1659x2212. CFP — 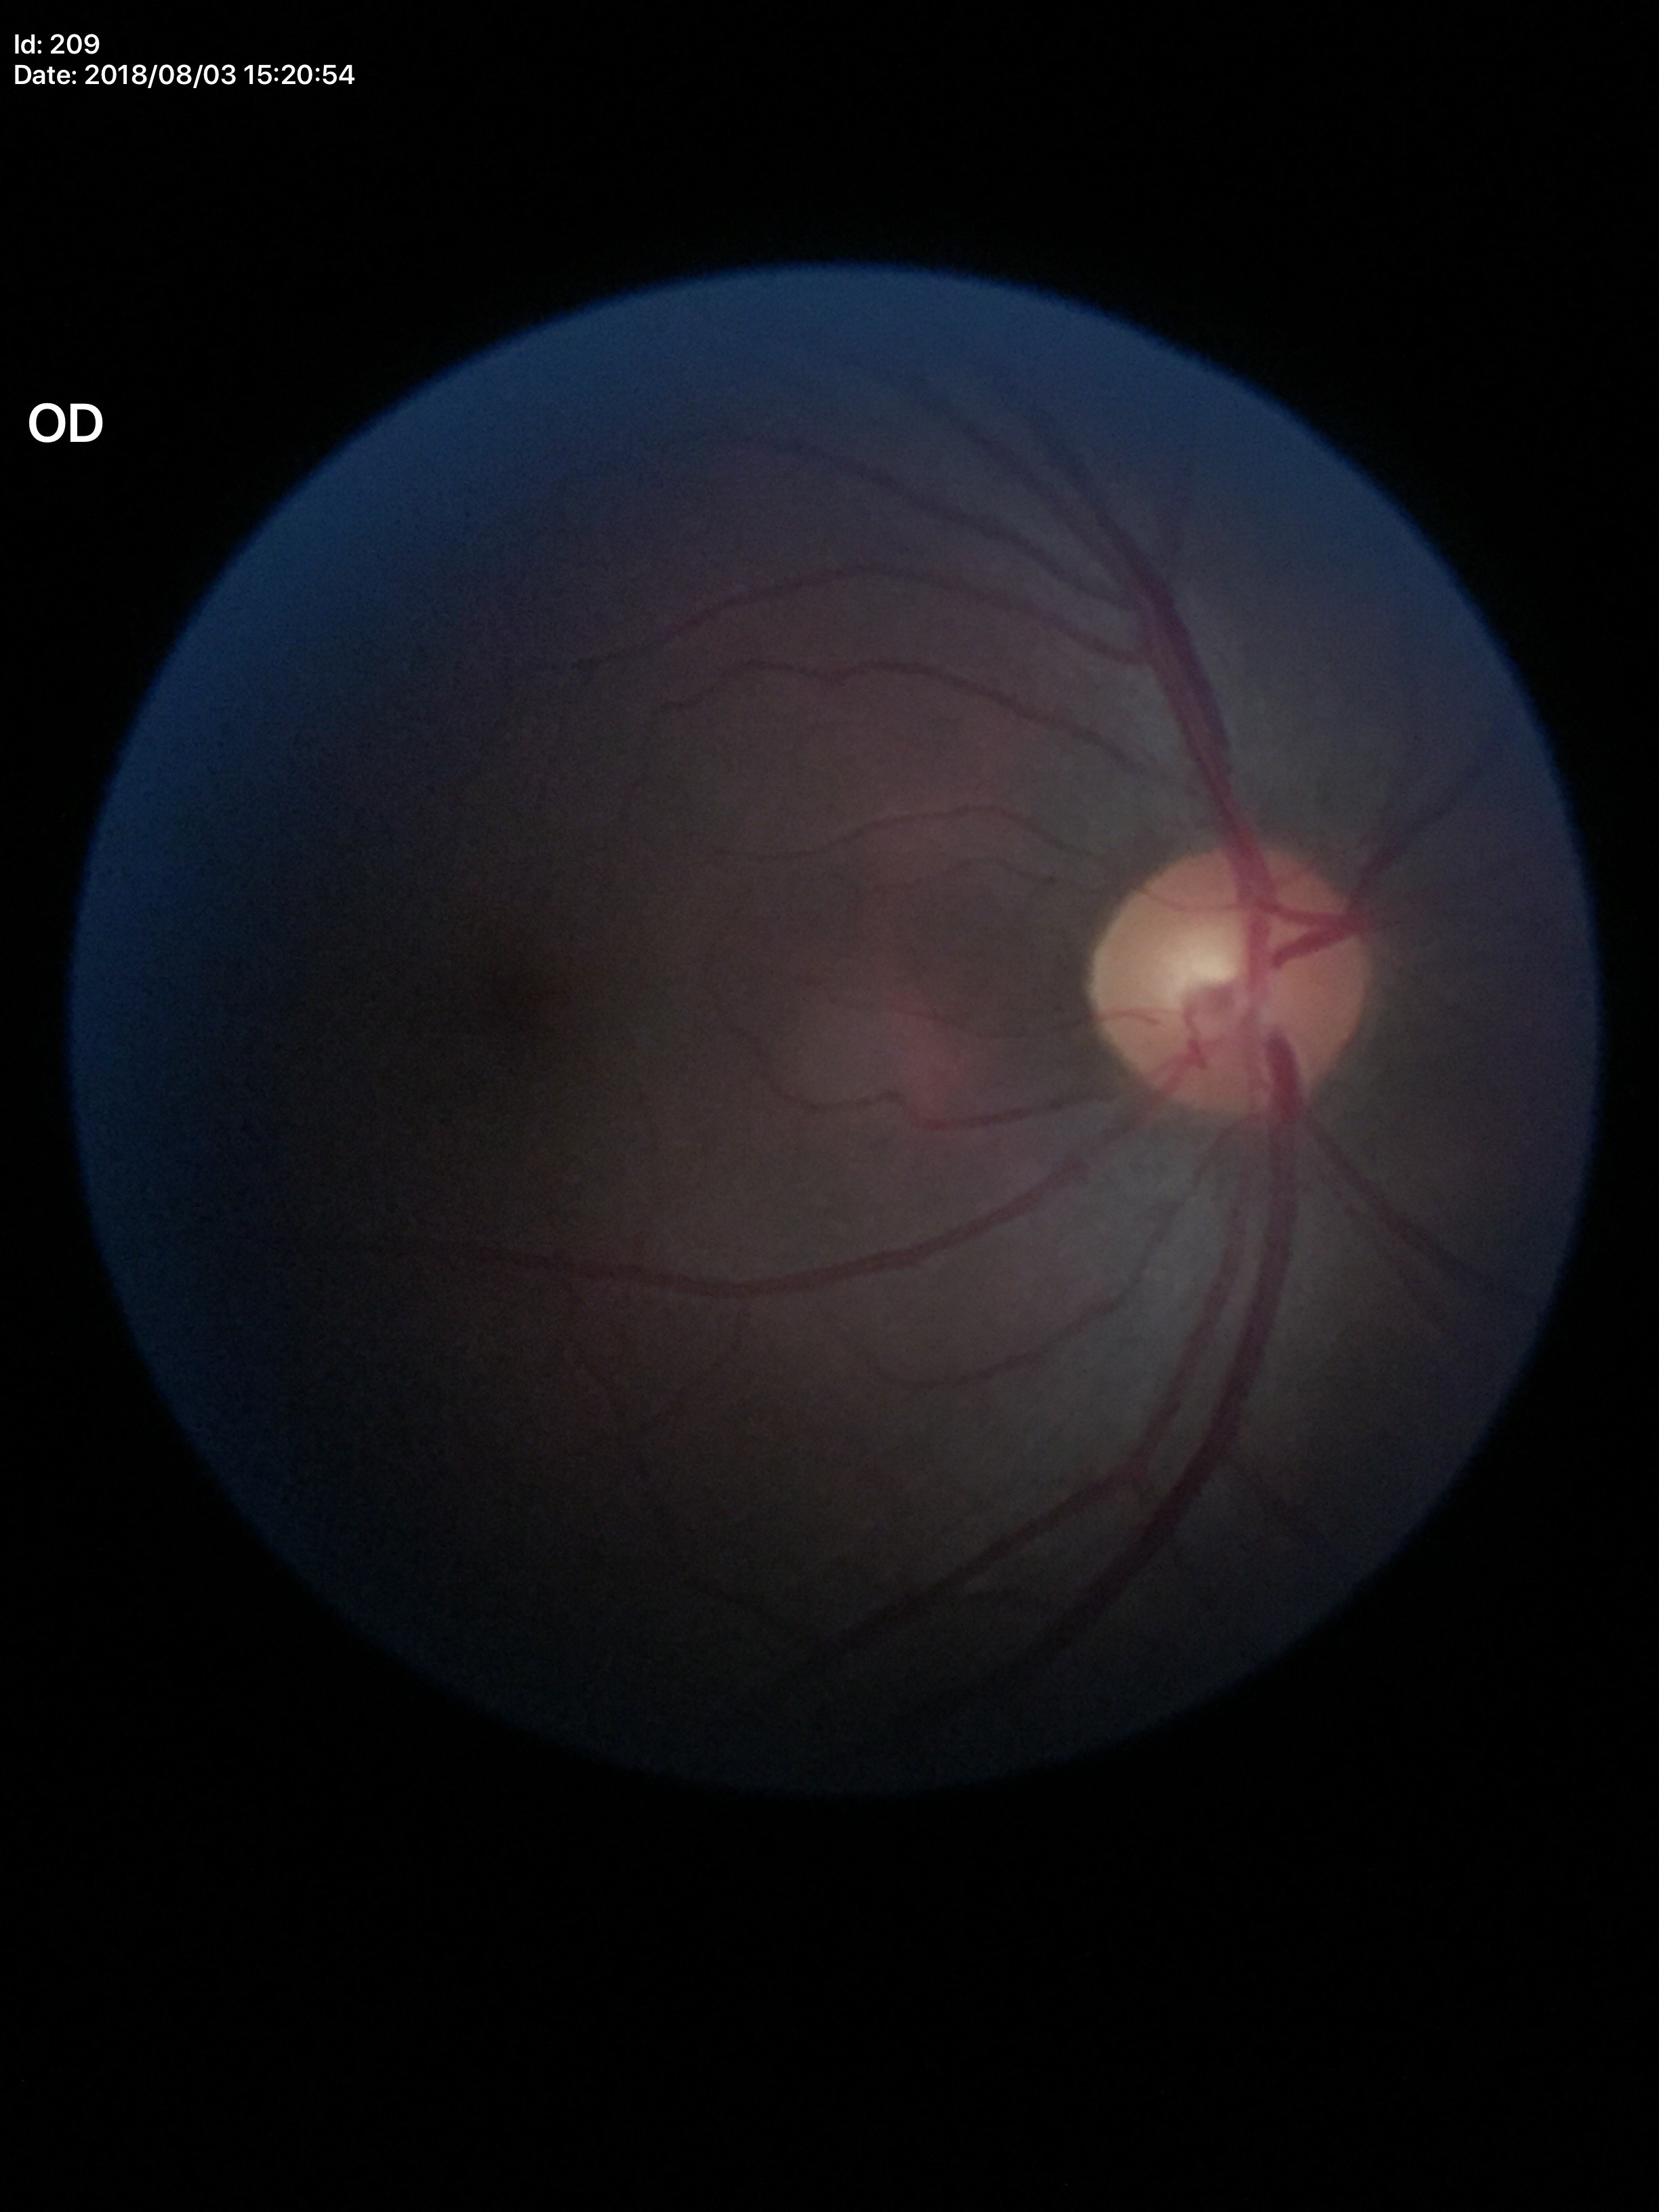
Vertical cup-to-disc ratio: 0.49.
Glaucoma assessment: not suspect.